Nonmydriatic:
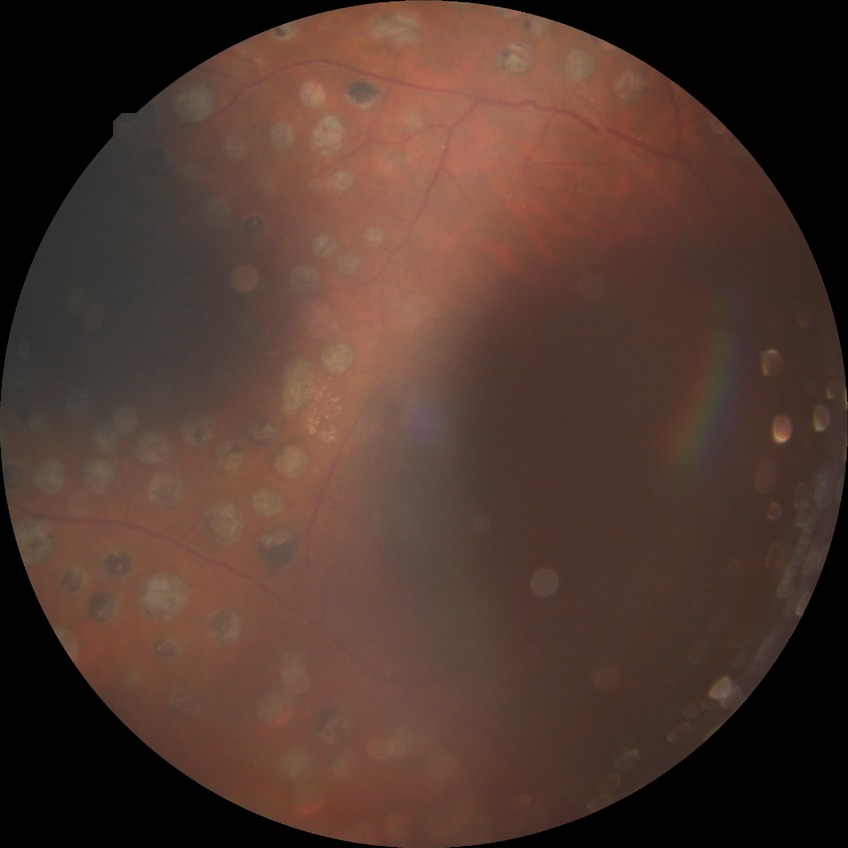 diabetic retinopathy (DR) = PDR (proliferative diabetic retinopathy).